Image size 1240x1240 · 100° field of view (Phoenix ICON) · Phoenix ICON wide-field infant fundus image:
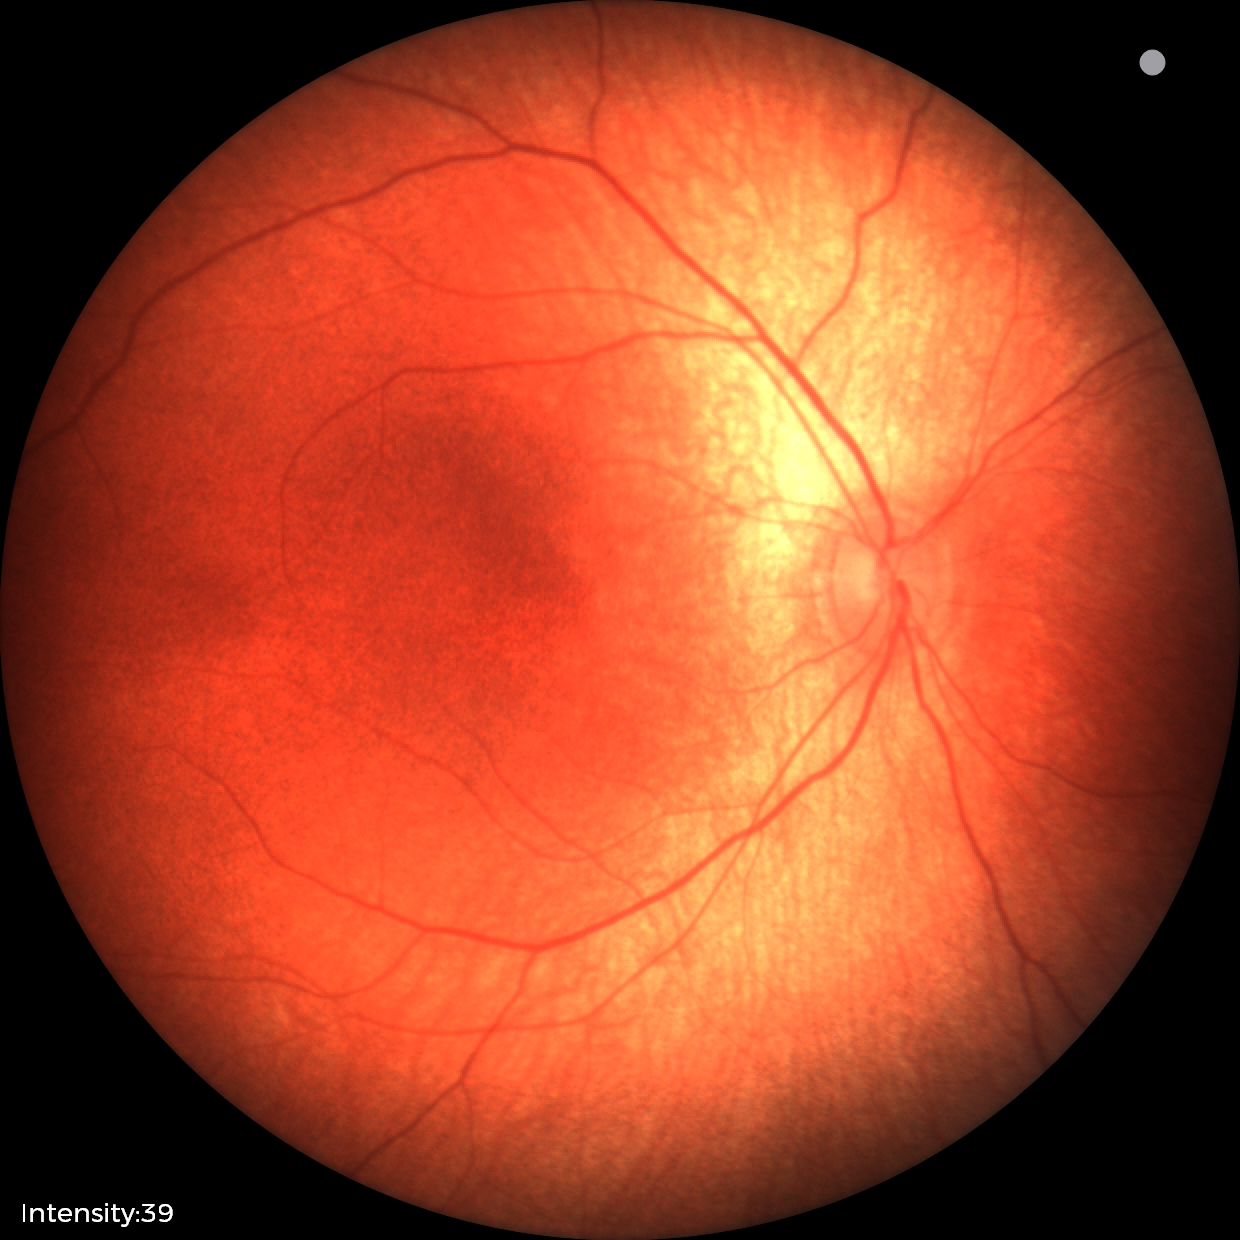
Assessment: normal fundus examination.